640x480; wide-field fundus image from infant ROP screening: 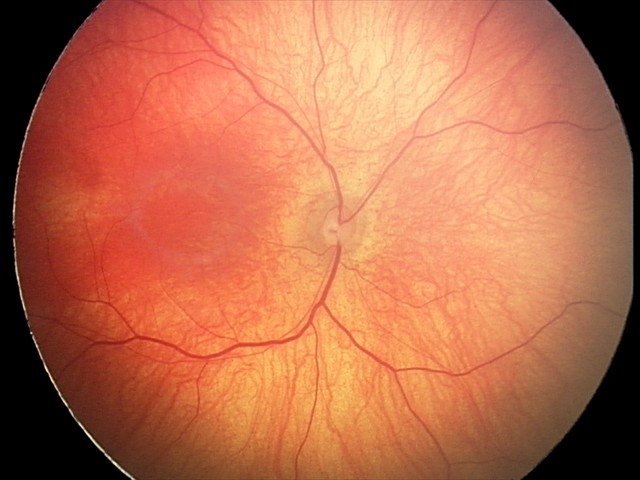

Q: What was the screening finding?
A: normal fundus examination